Ultra-widefield (UWF) fundus image · 1924 x 1556 pixels · FOV: 200 degrees:
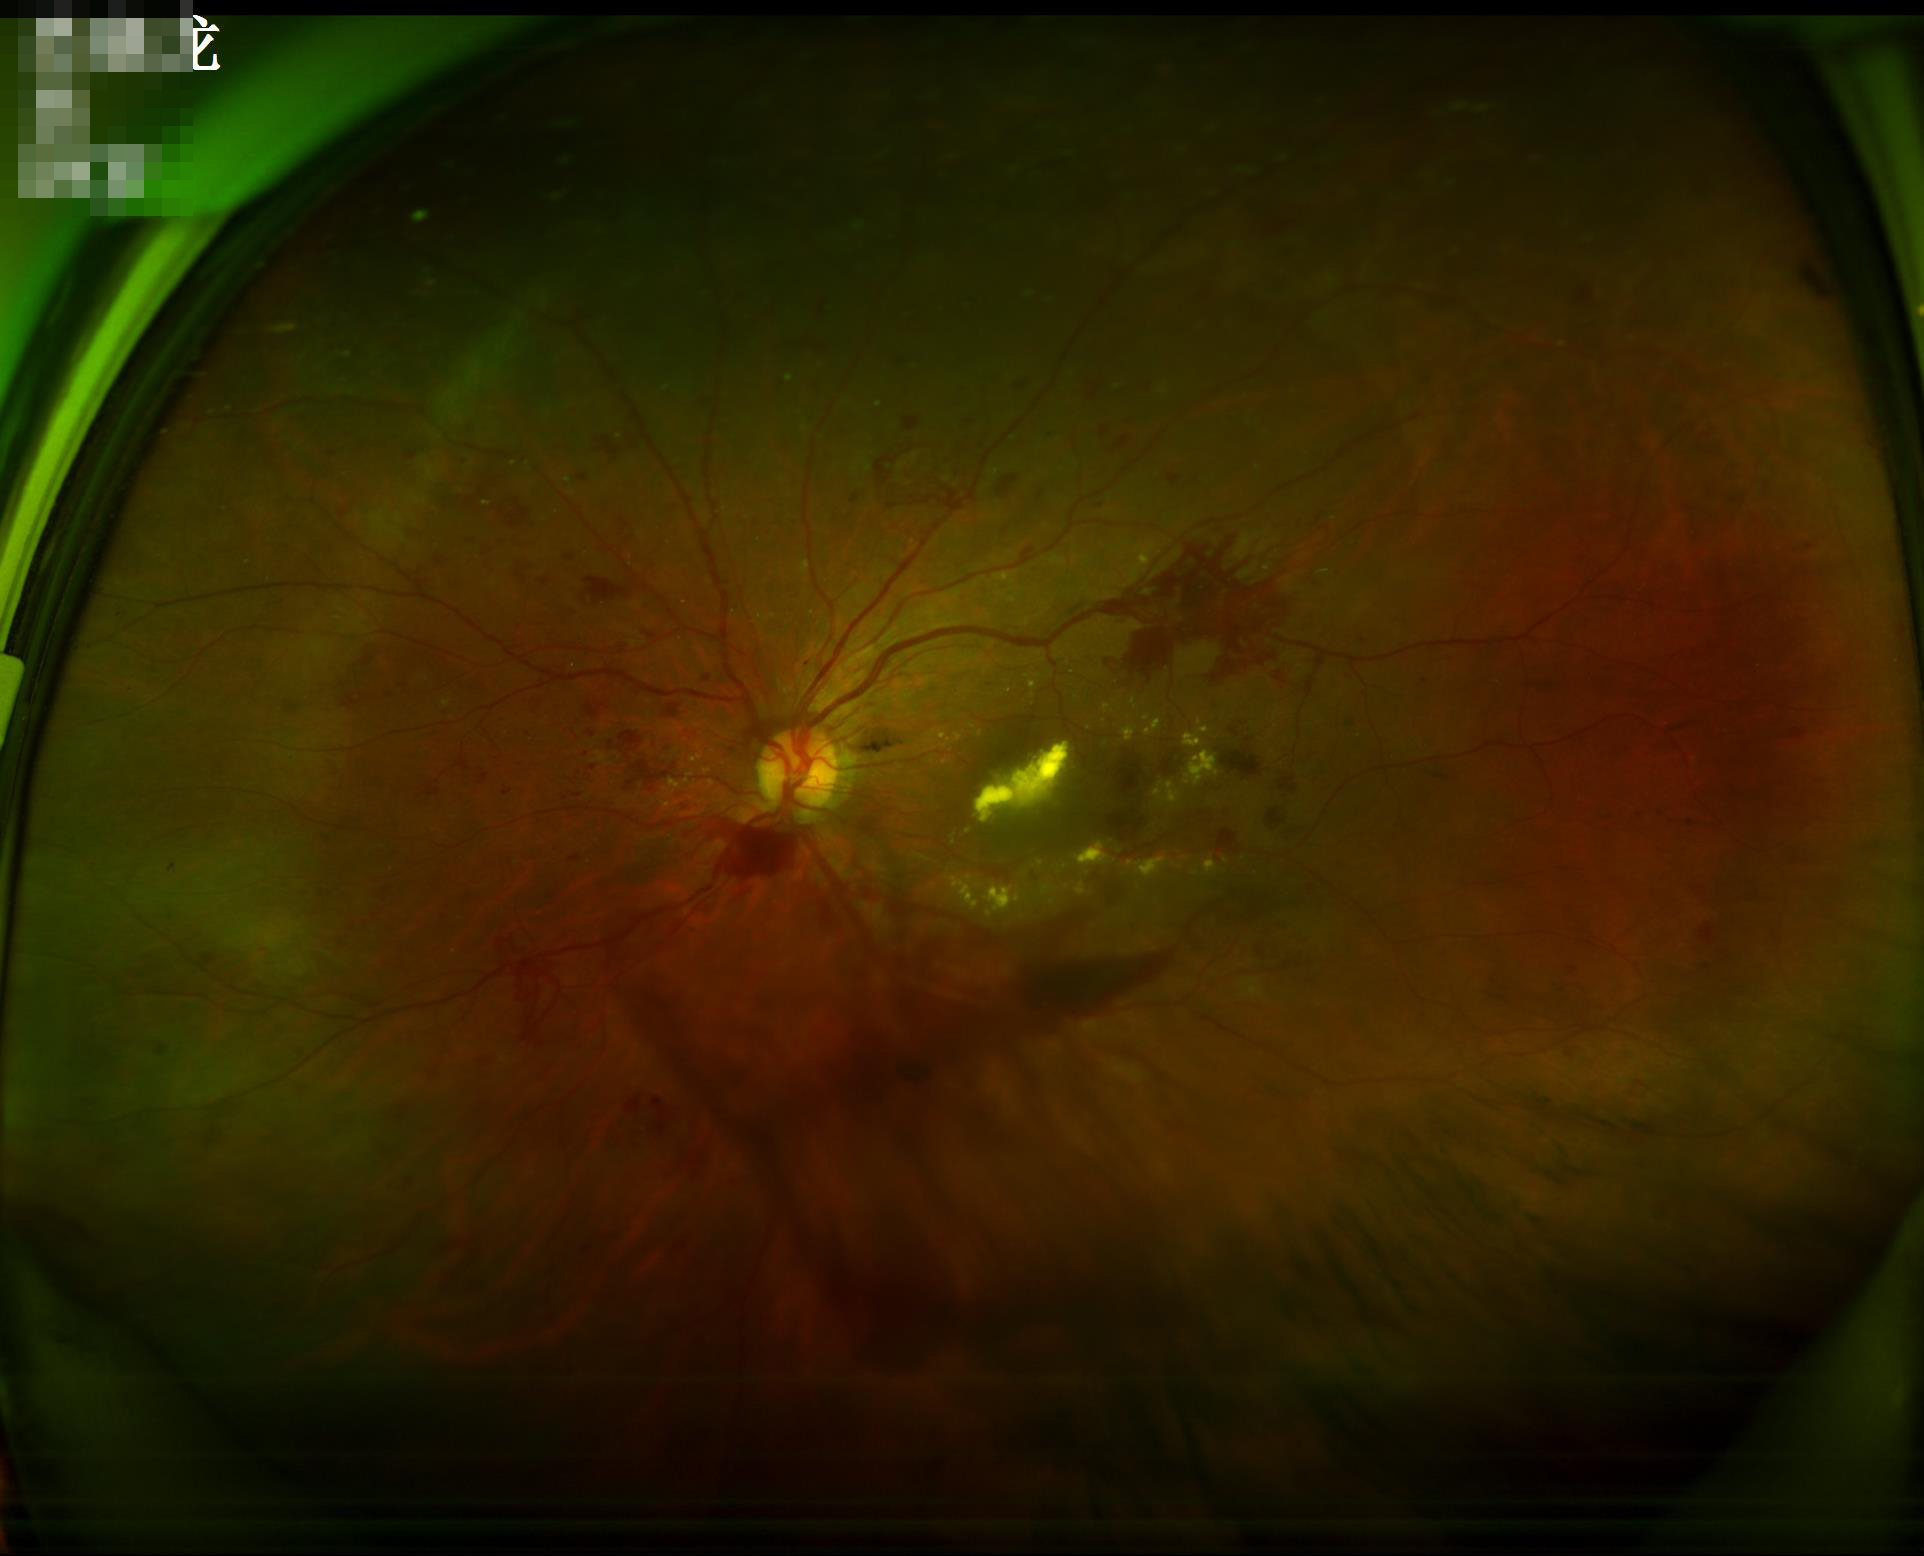 Poor illumination with uneven exposure. Good dynamic range. Optic disc, vessels, and background are in focus.